Posterior pole field covering the optic disc and macula — 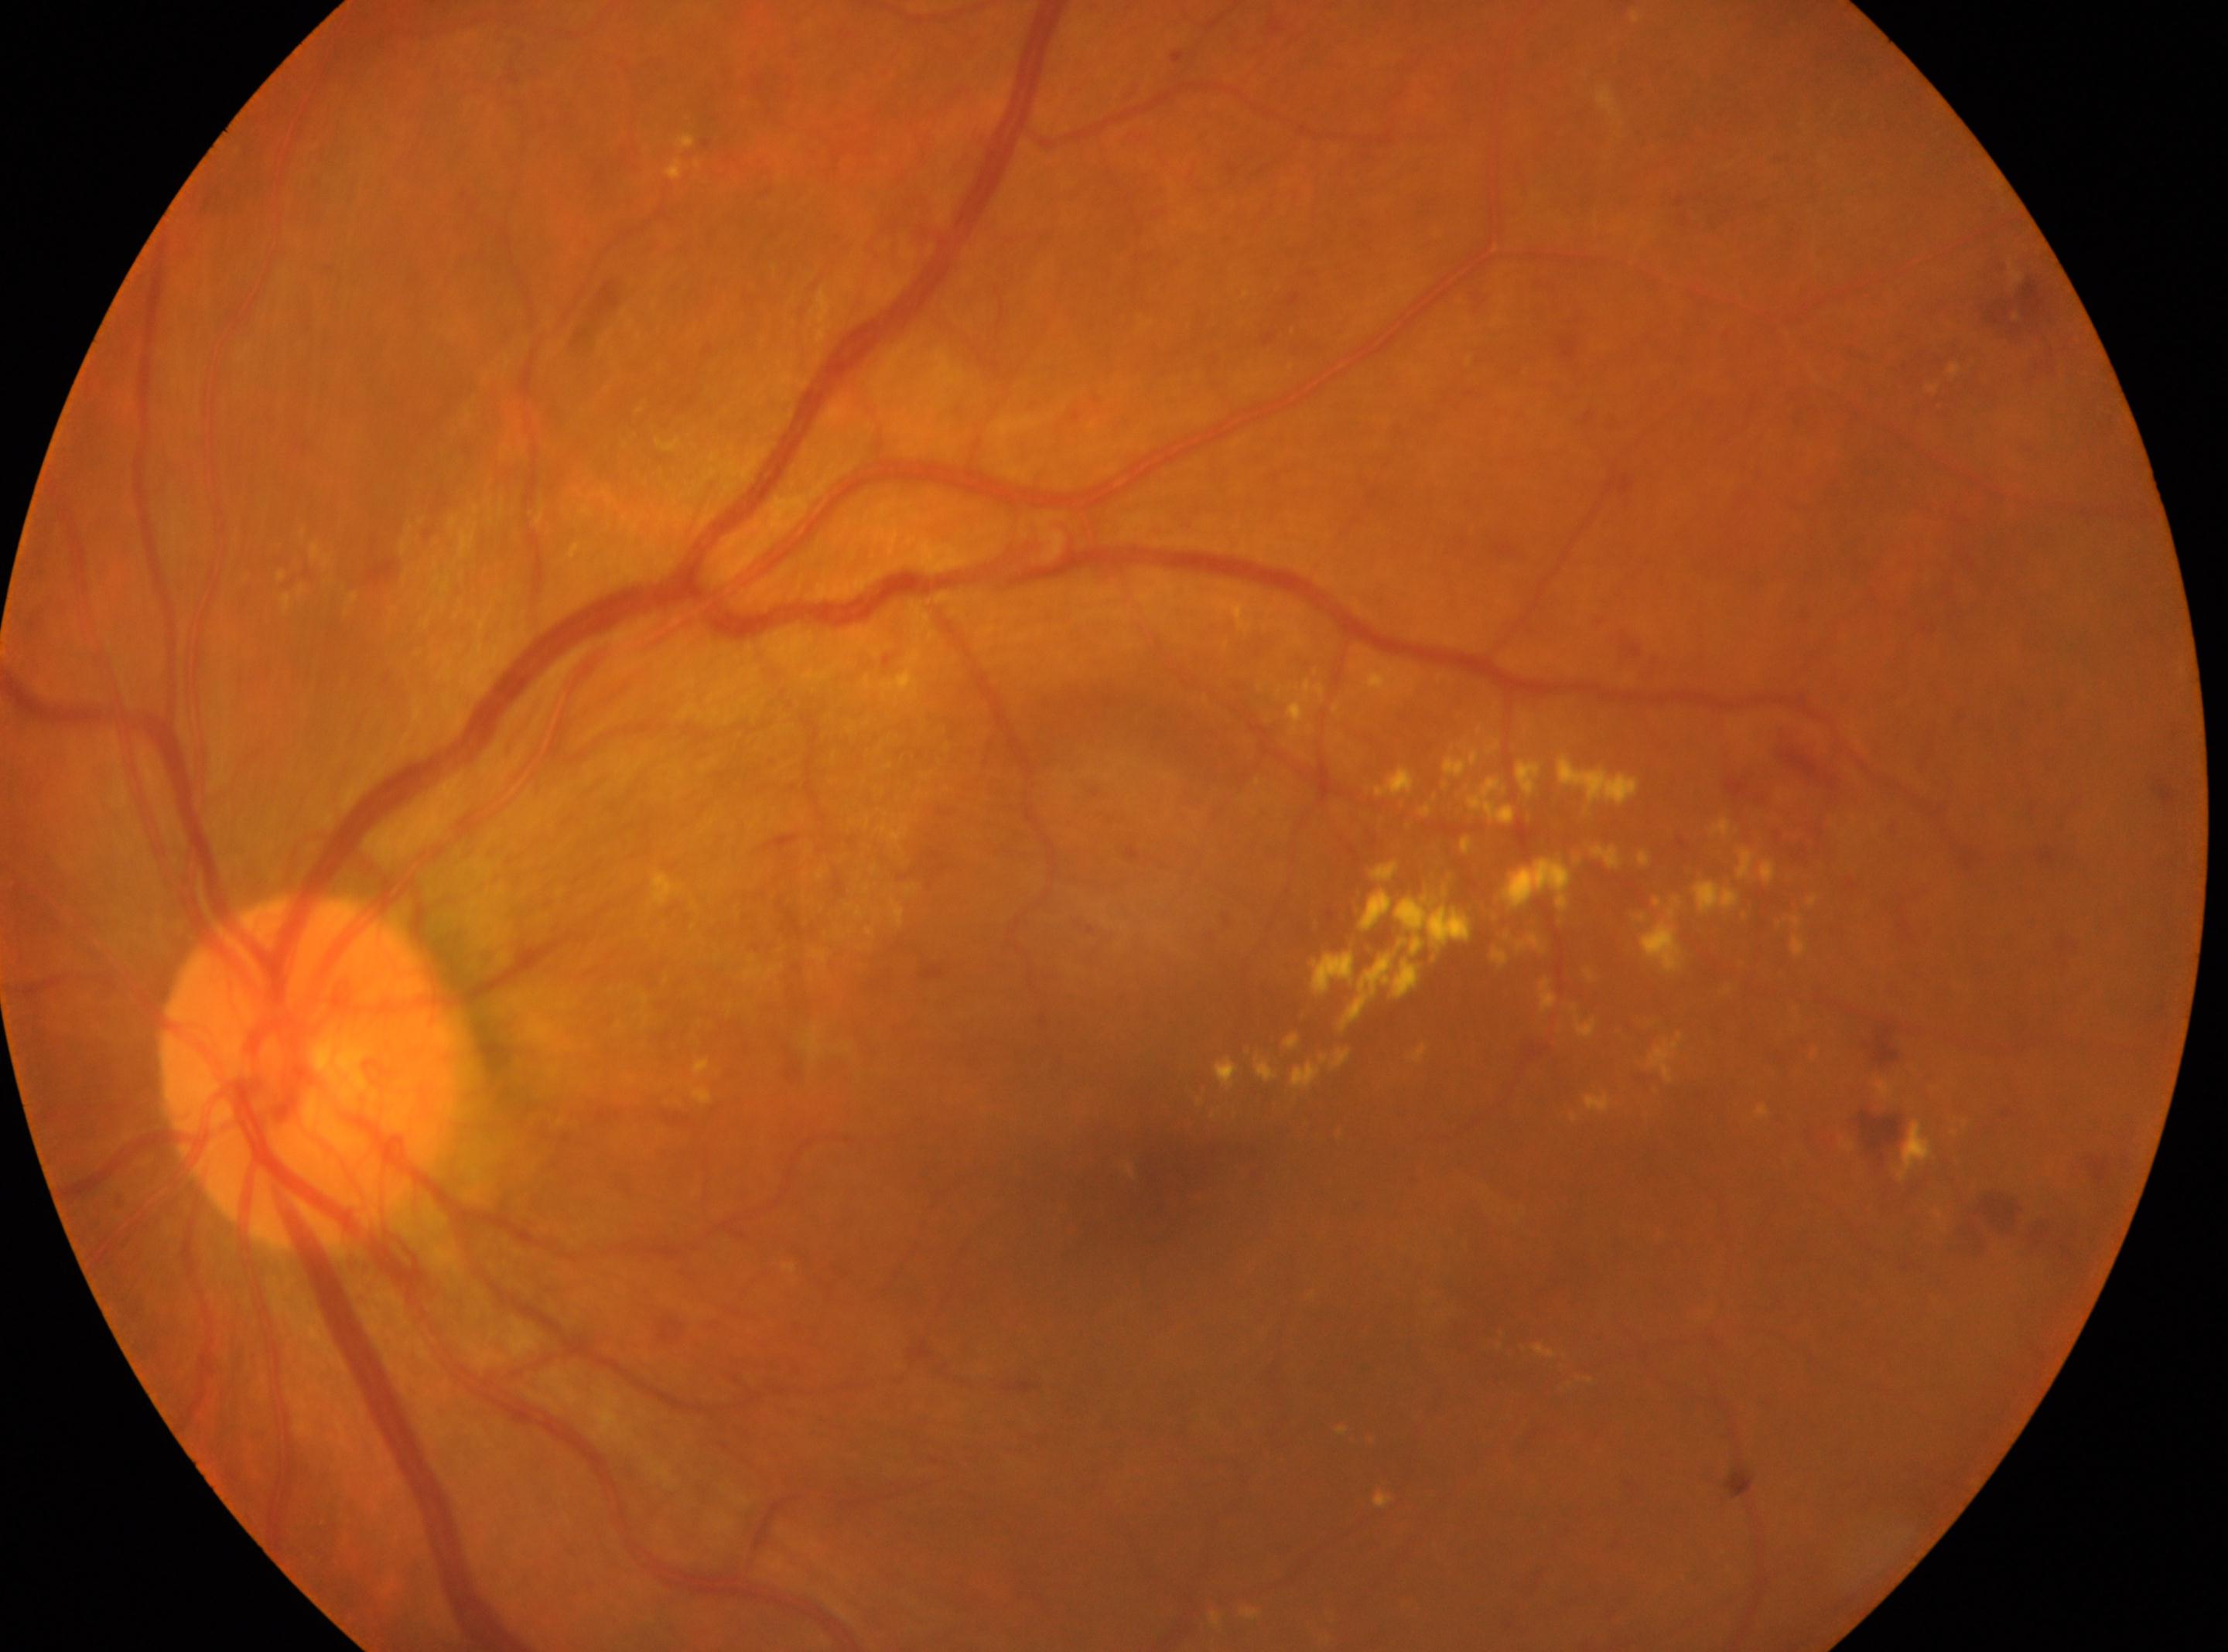

DR class: proliferative diabetic retinopathy; macular center: x=1150, y=1190; ONH: x=308, y=1070; laterality: left eye; DR stage: PDR (grade 4).